Color fundus image · without pupil dilation:
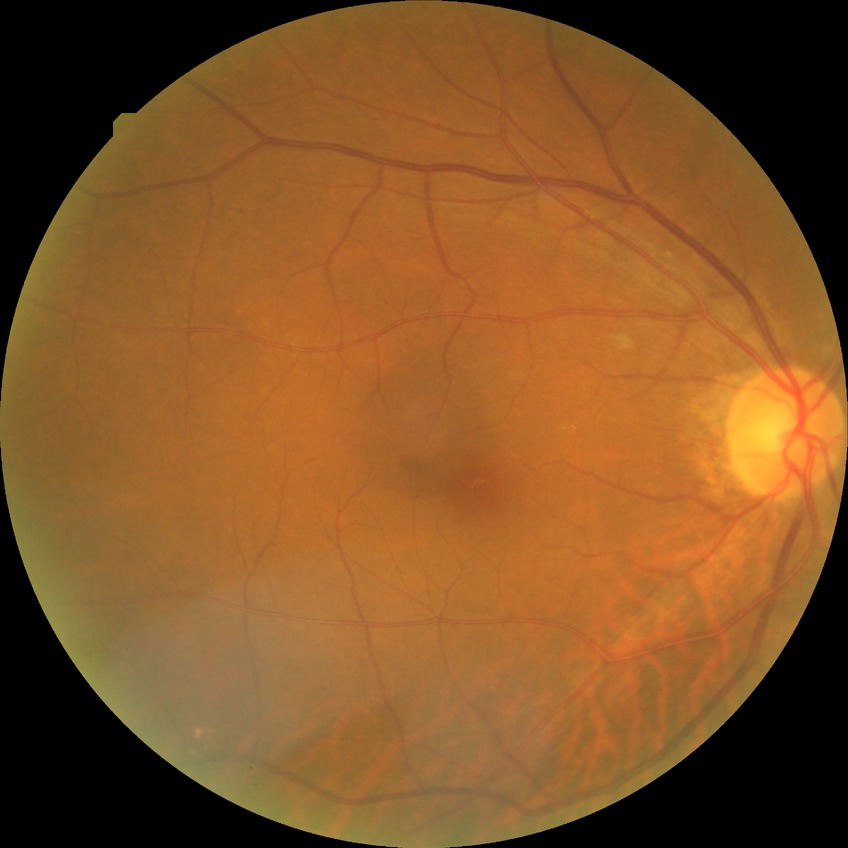
Annotations:
– diabetic retinopathy (DR): no diabetic retinopathy (NDR)